2048 x 1536 pixels; CFP; FOV: 45 degrees
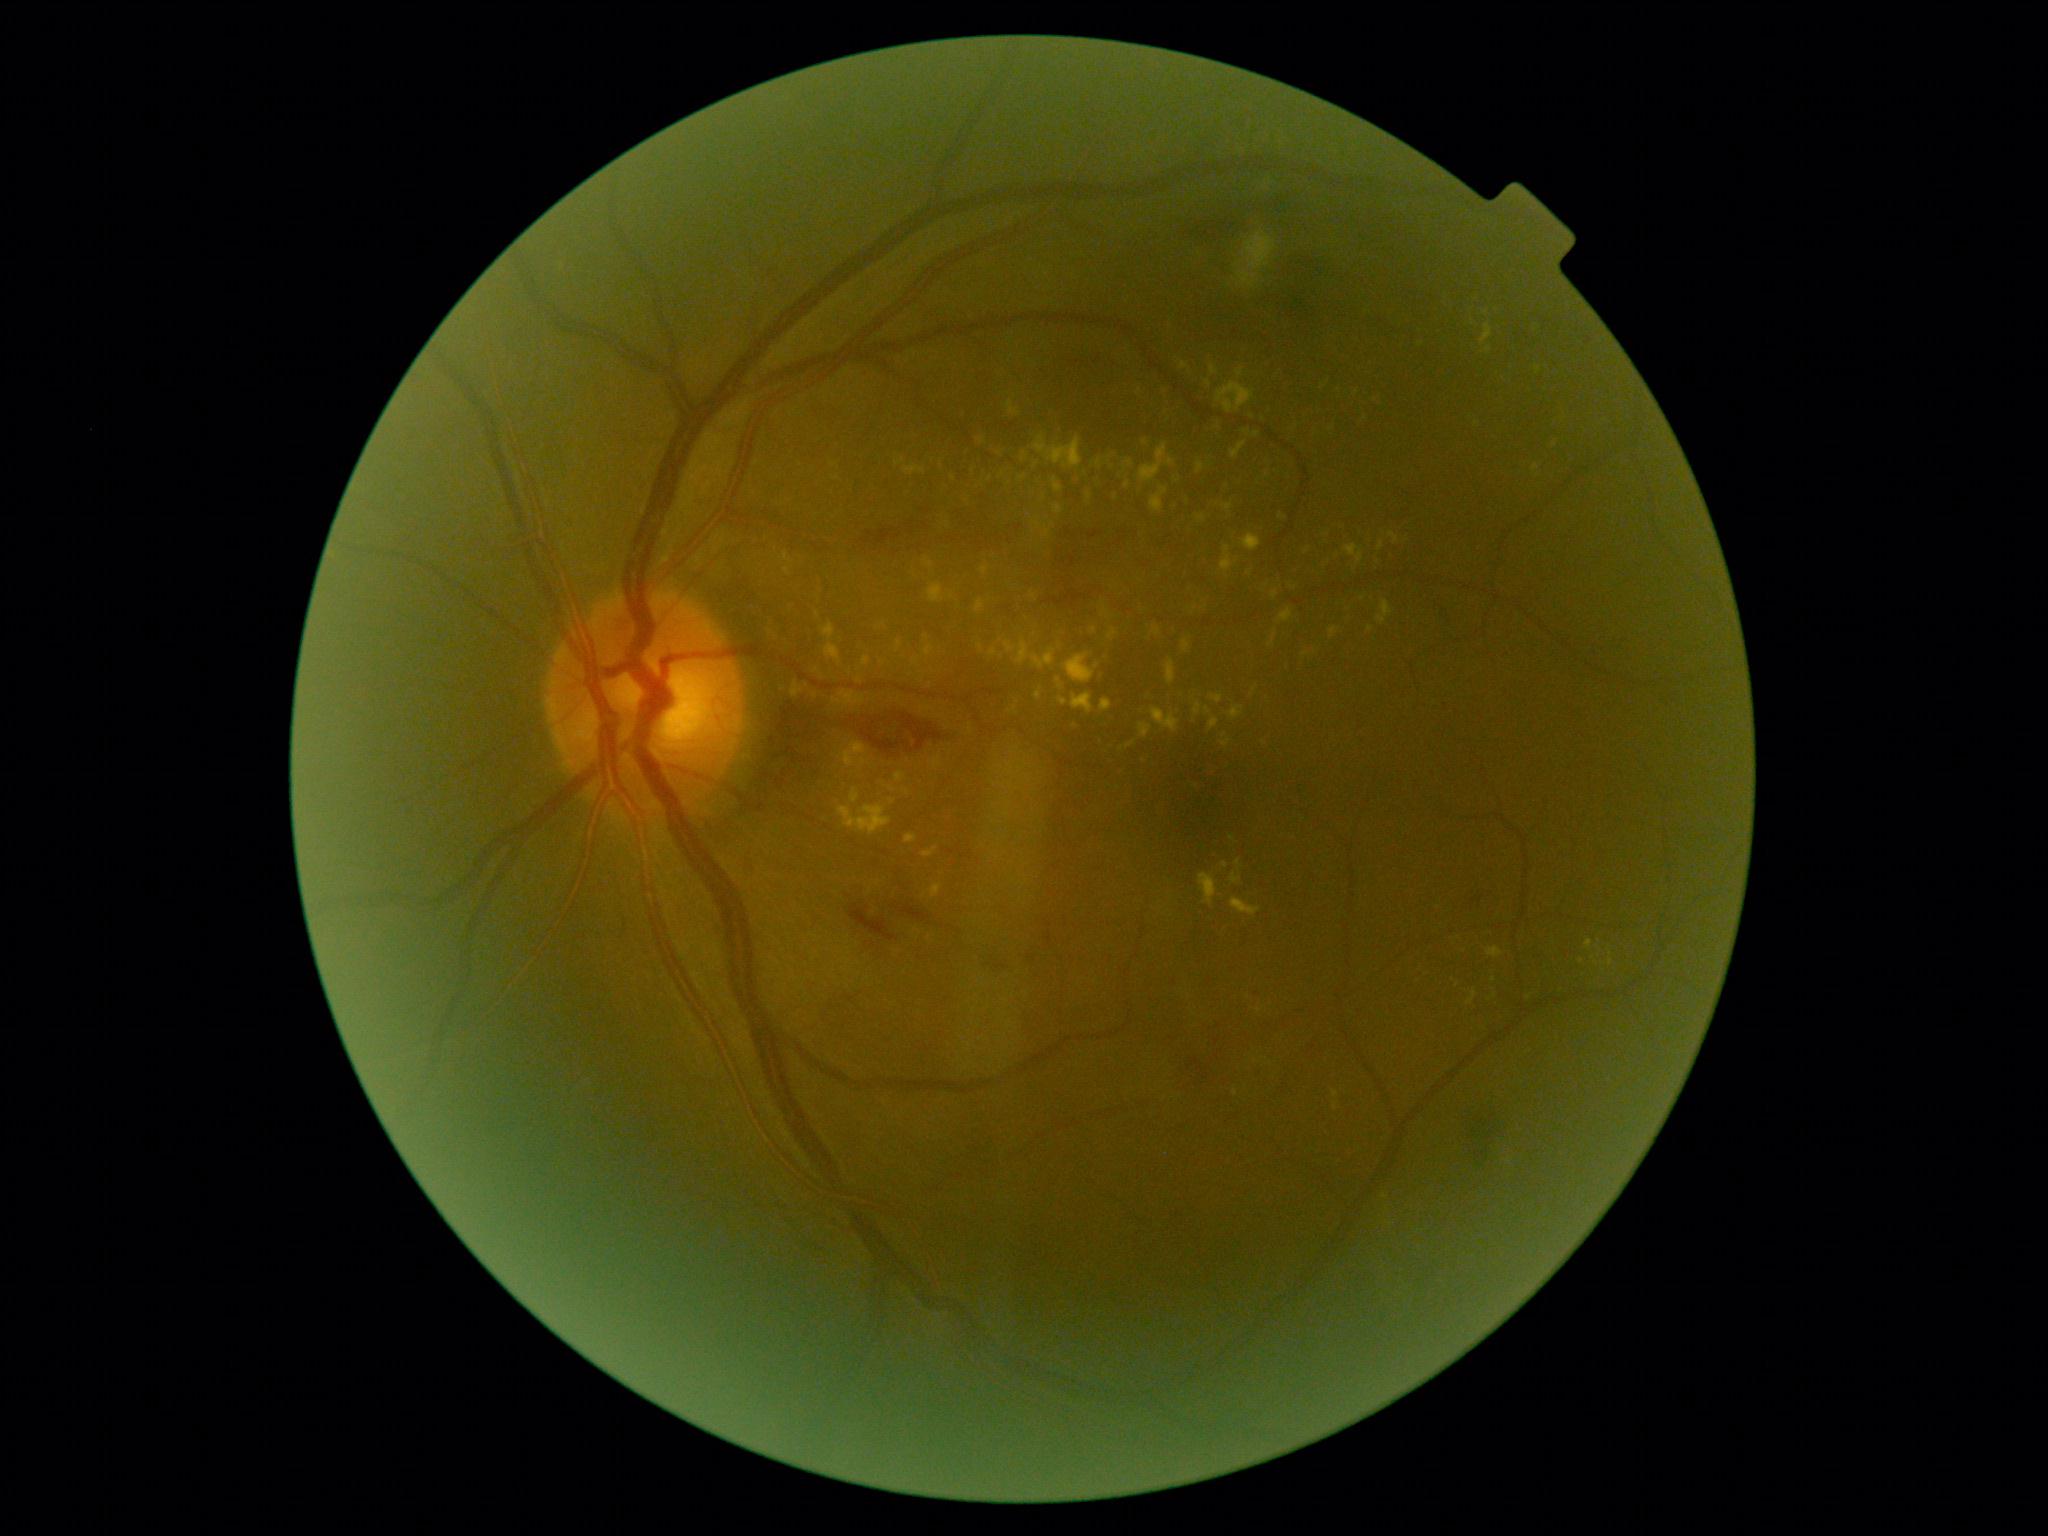
DR grade: 2/4.